Captured after pupil dilation, 50° field of view, 2228 by 1652 pixels
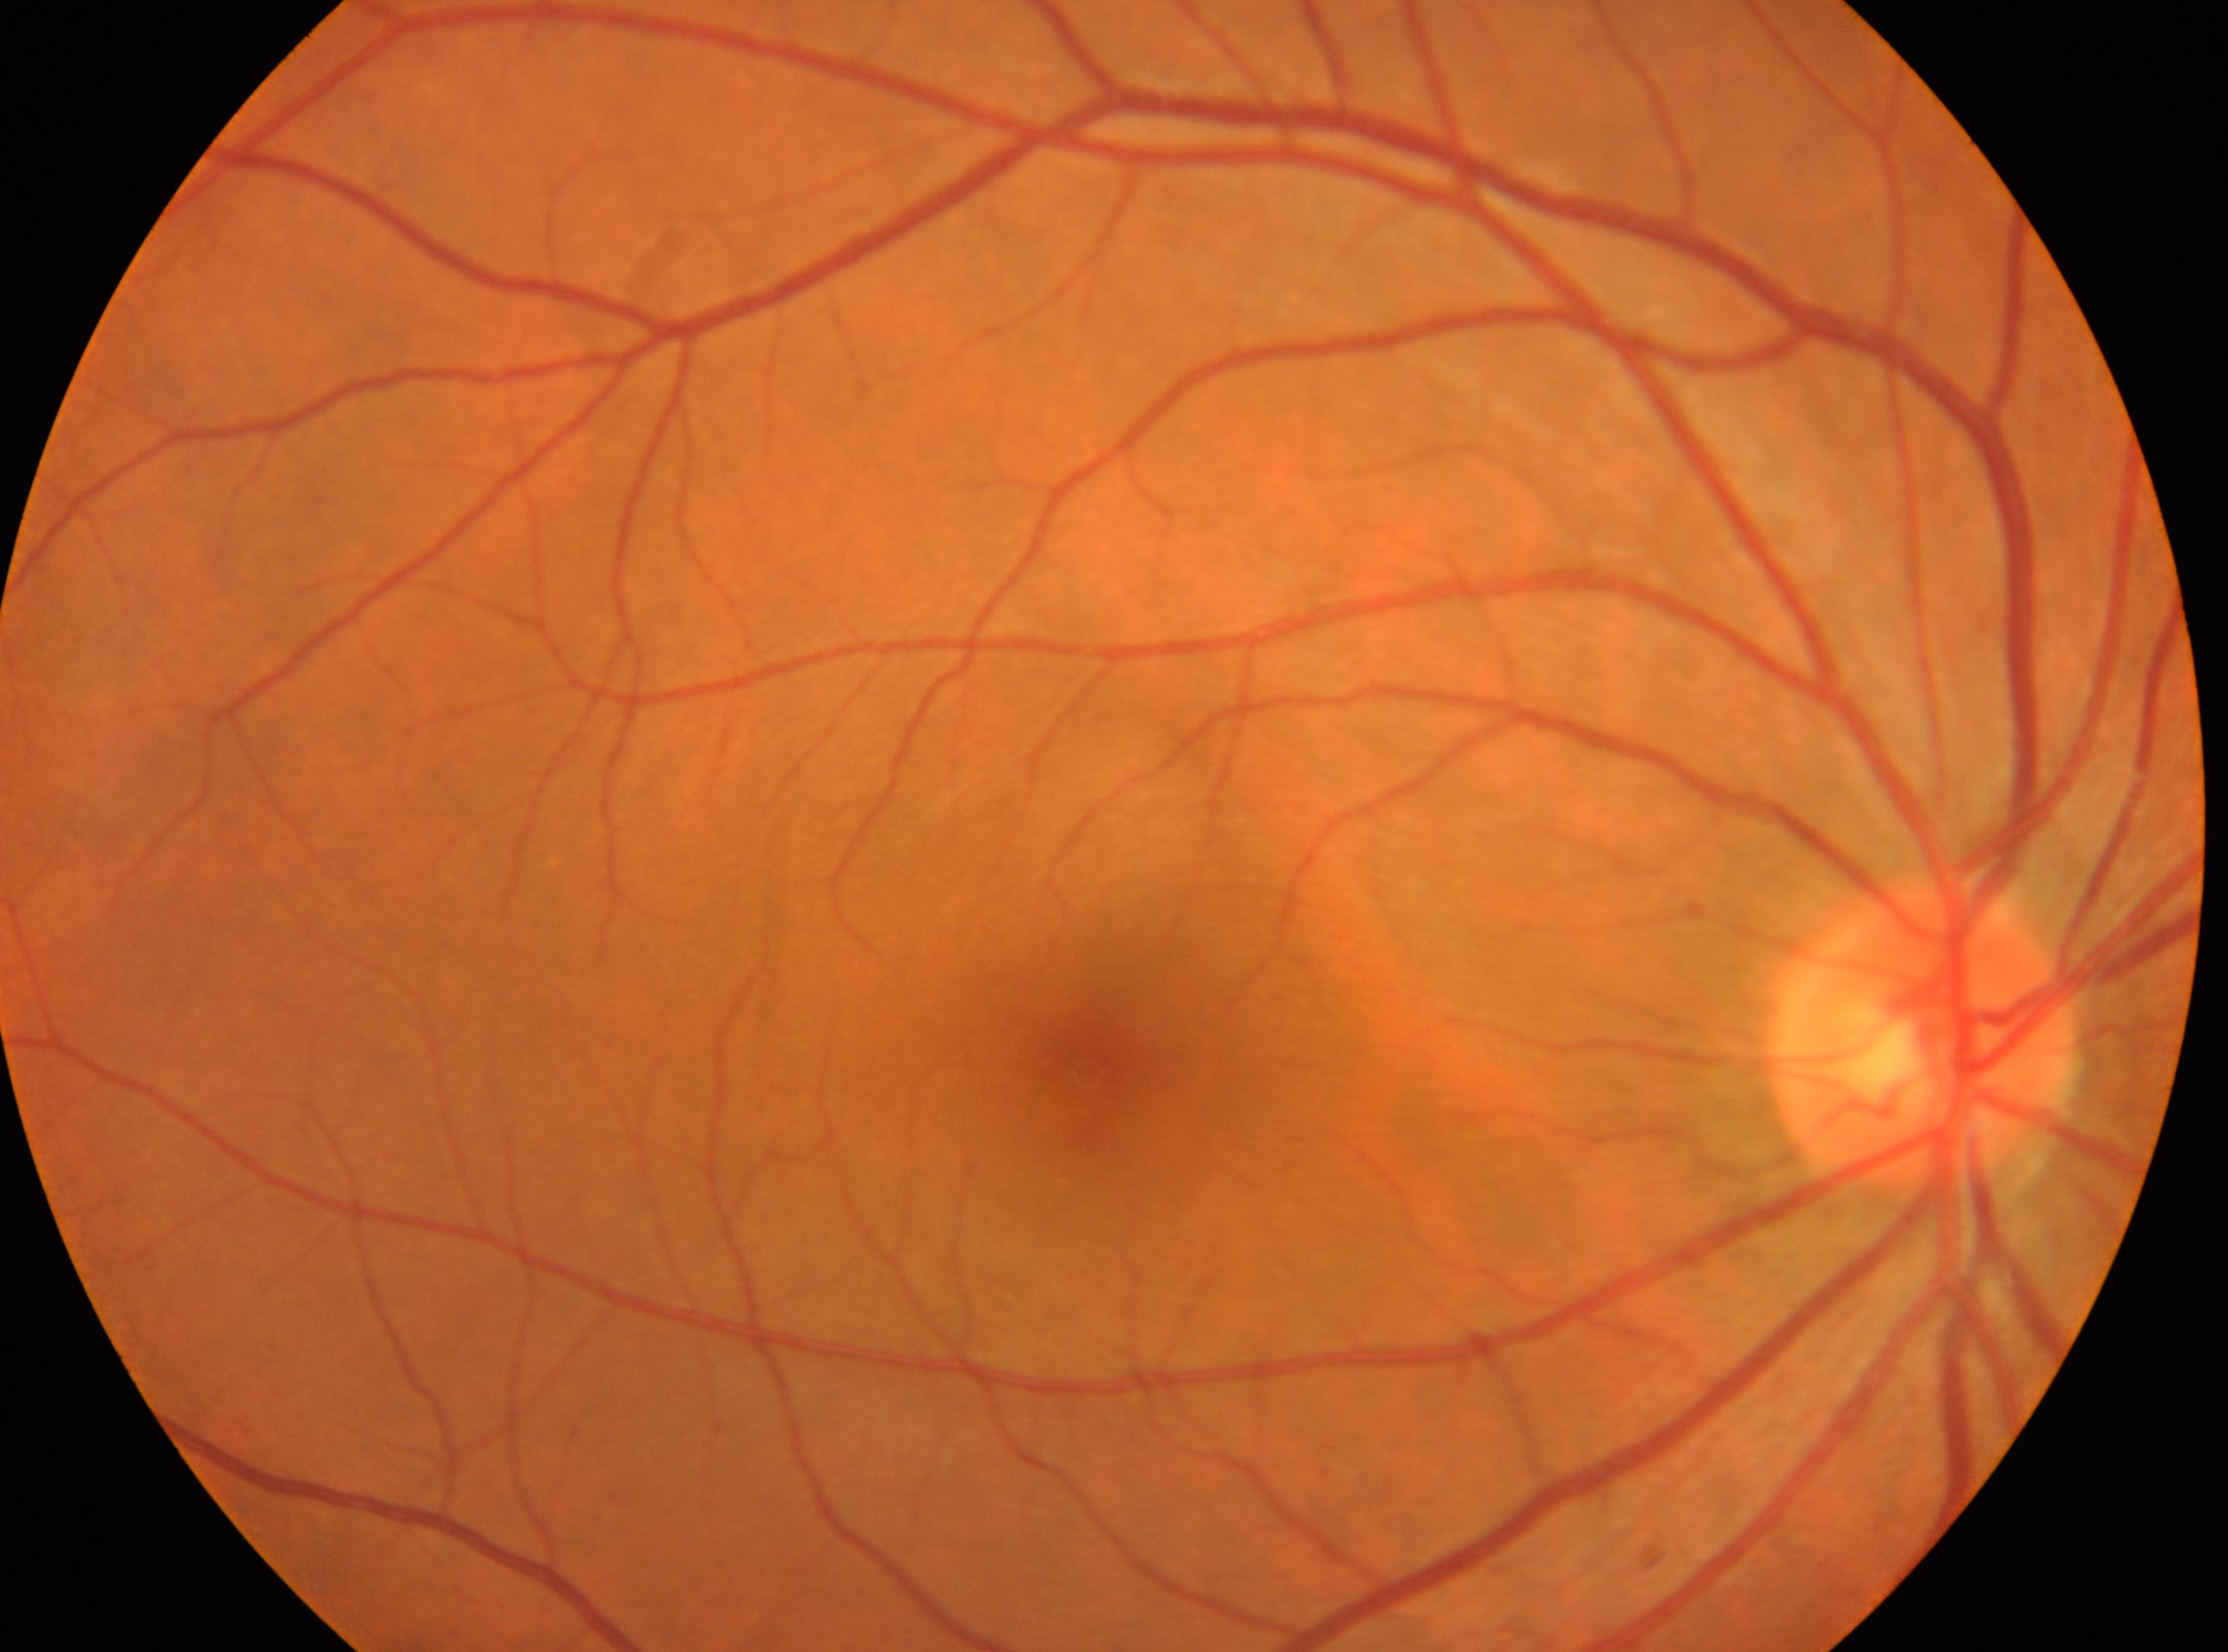

ONH: [1919, 1032]; diabetic retinopathy: grade 0 — no visible signs of diabetic retinopathy; fovea center: [1088, 1070]; right eye; No diabetic retinopathy identified.